848x848 — 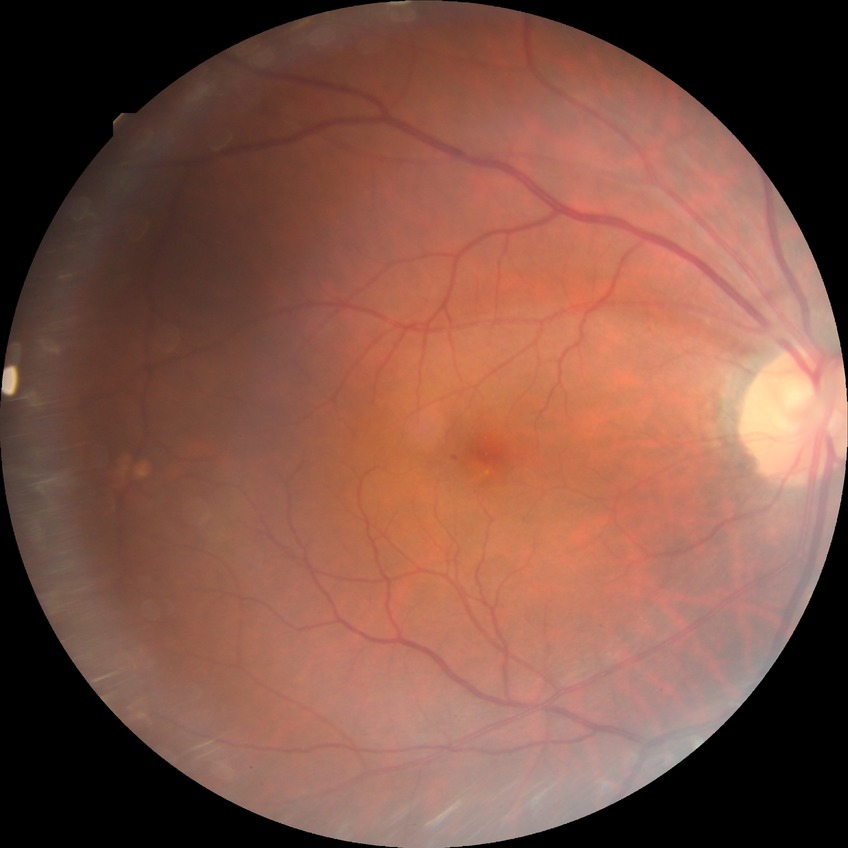

• DR: SDR